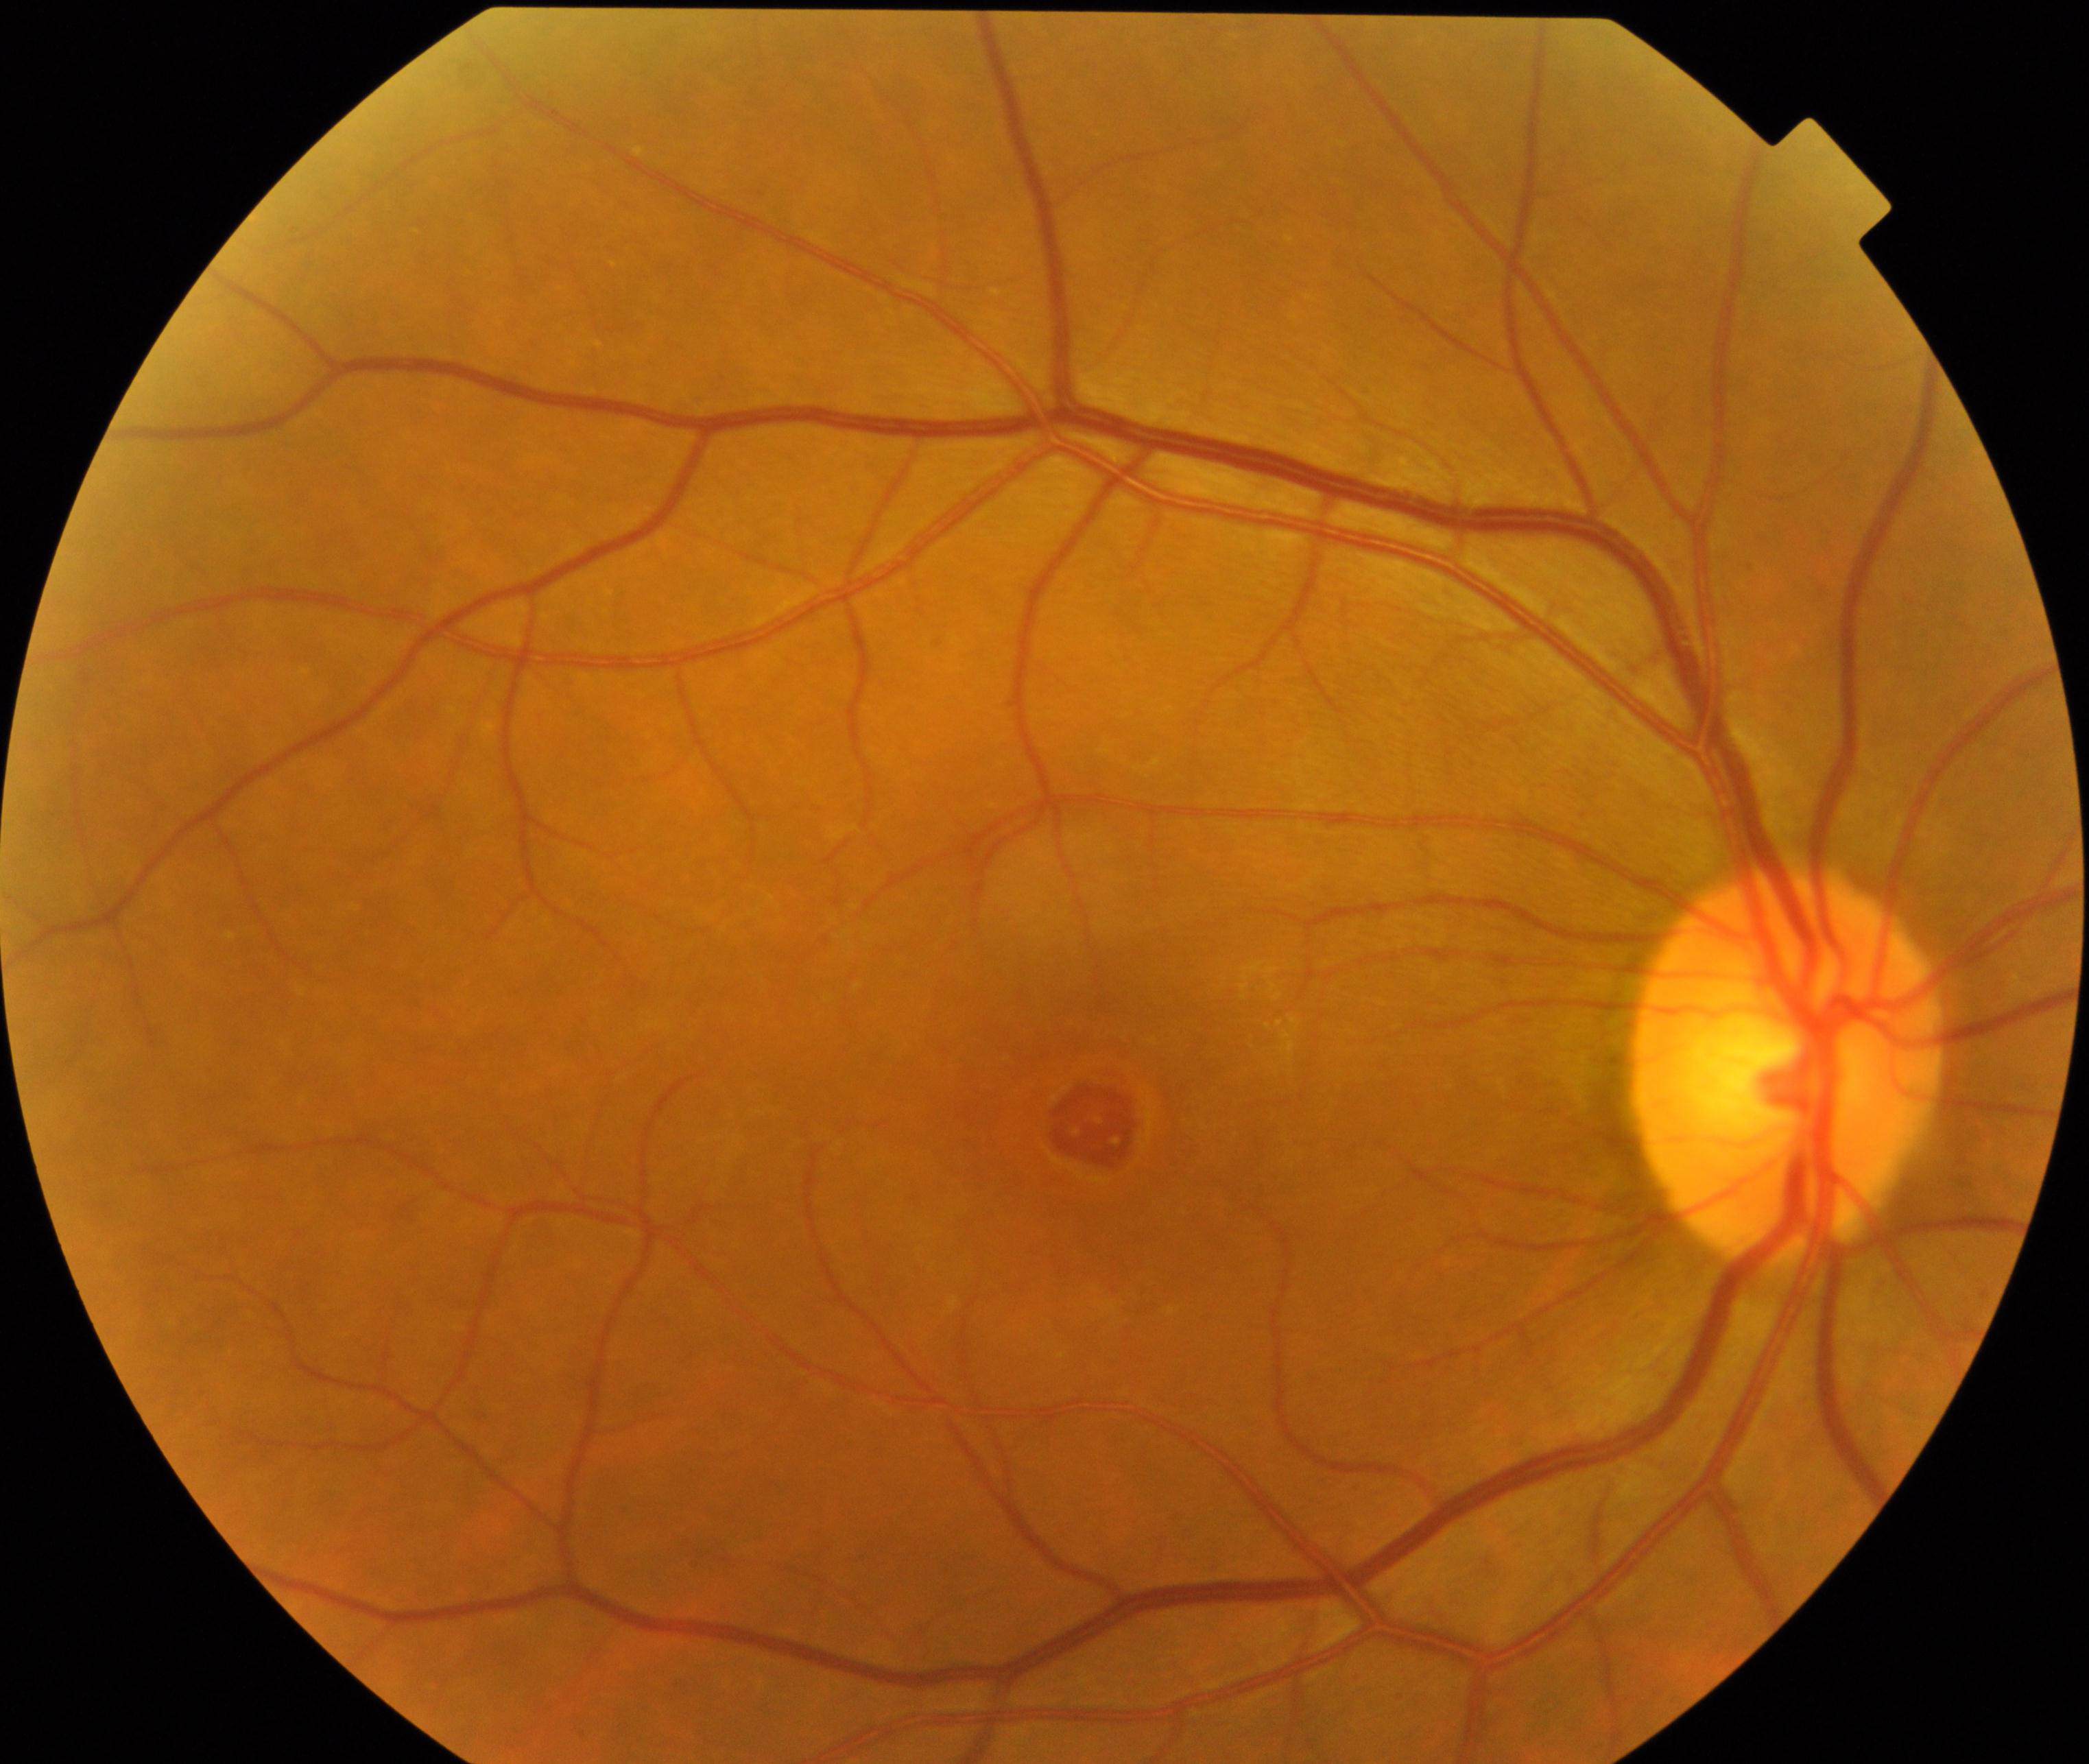
Diagnosis: macular hole. Typically showing central foveal defect, round or oval, sometimes with multiple yellow deposits within the crater or a surrounding cuff of subretinal fluid.